Nonmydriatic; 848 x 848 pixels; posterior pole color fundus photograph.
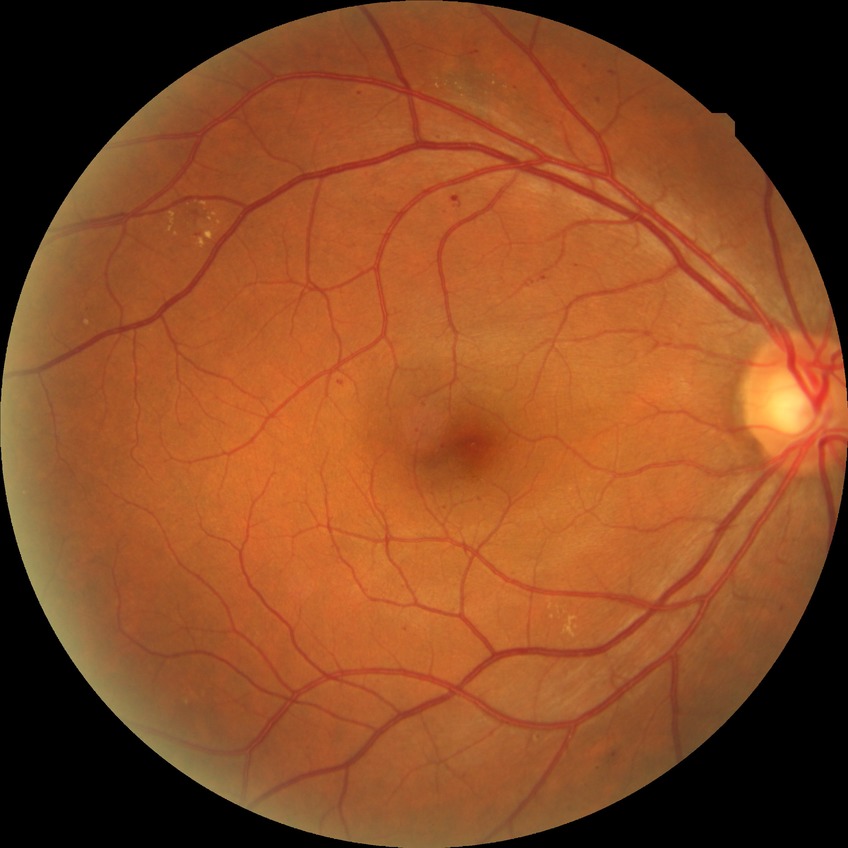

Diabetic retinopathy (DR): simple diabetic retinopathy (SDR).